Nonmydriatic fundus photograph:
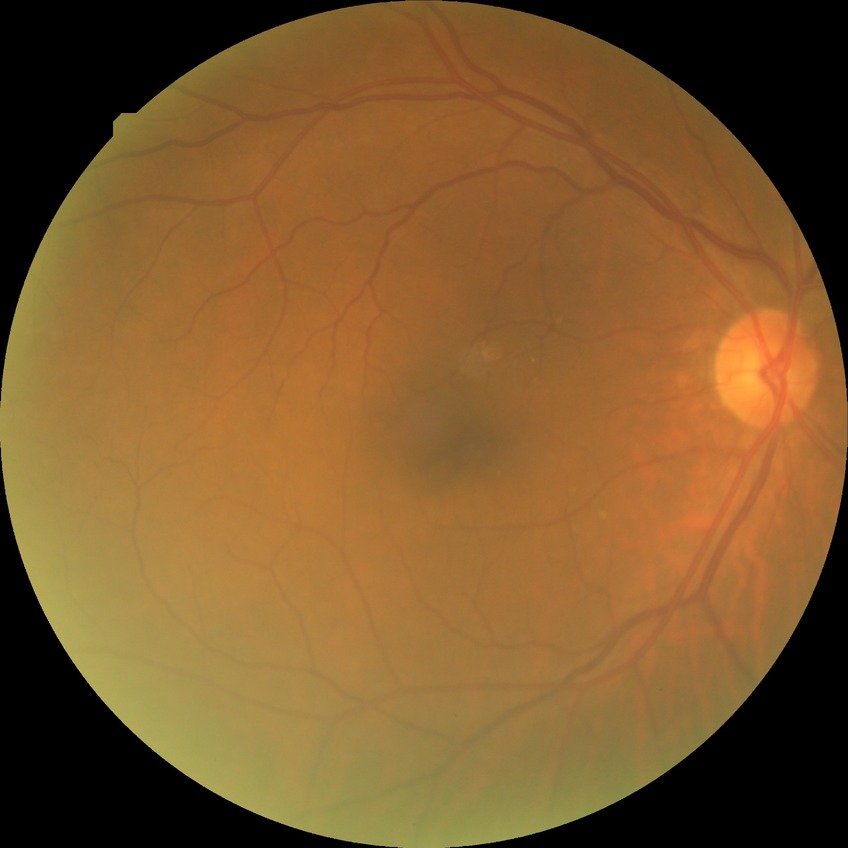
Diabetic retinopathy grade is no diabetic retinopathy.